CFP; diabetic retinopathy graded by the modified Davis classification: 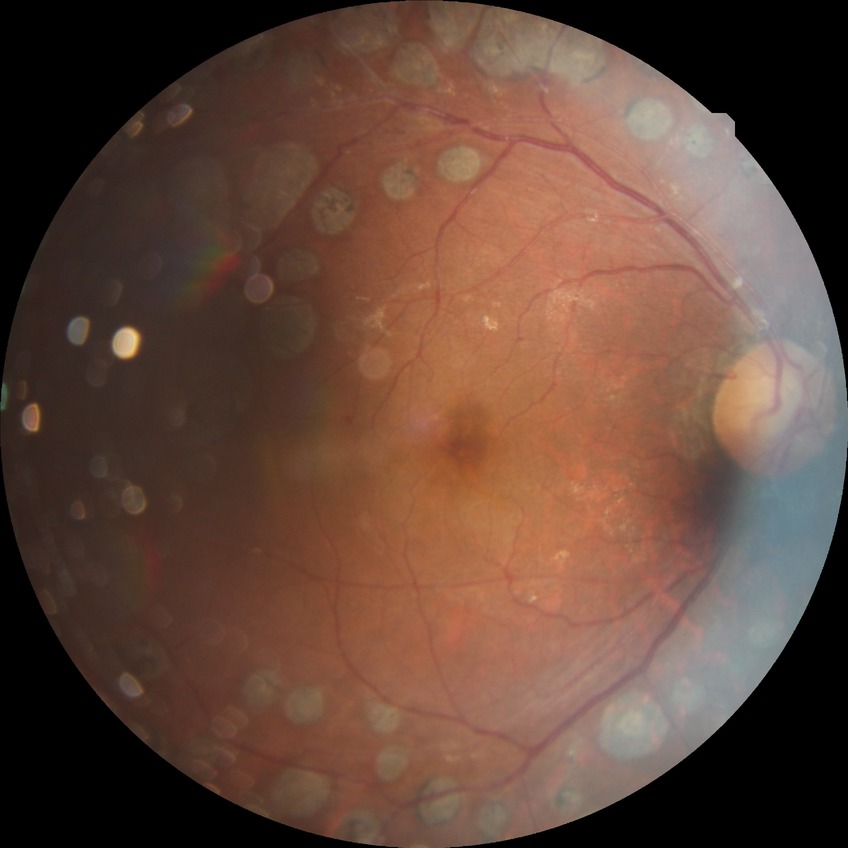
Diabetic retinopathy (DR) is PDR (proliferative diabetic retinopathy).